Modified Davis grading — 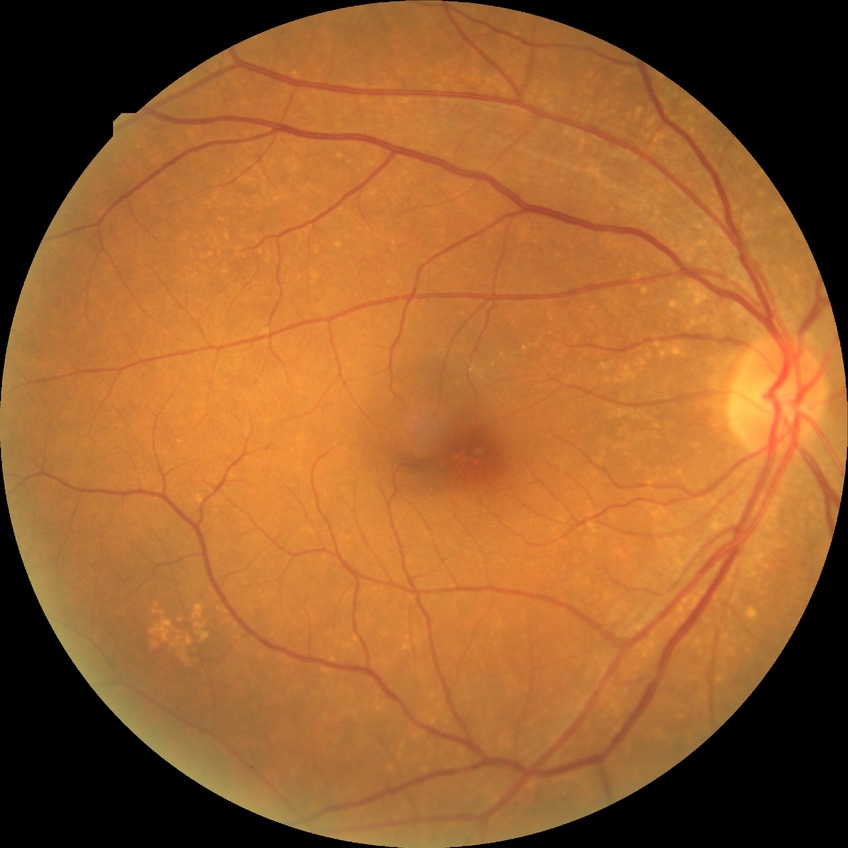
Diabetic retinopathy (DR): no diabetic retinopathy (NDR).